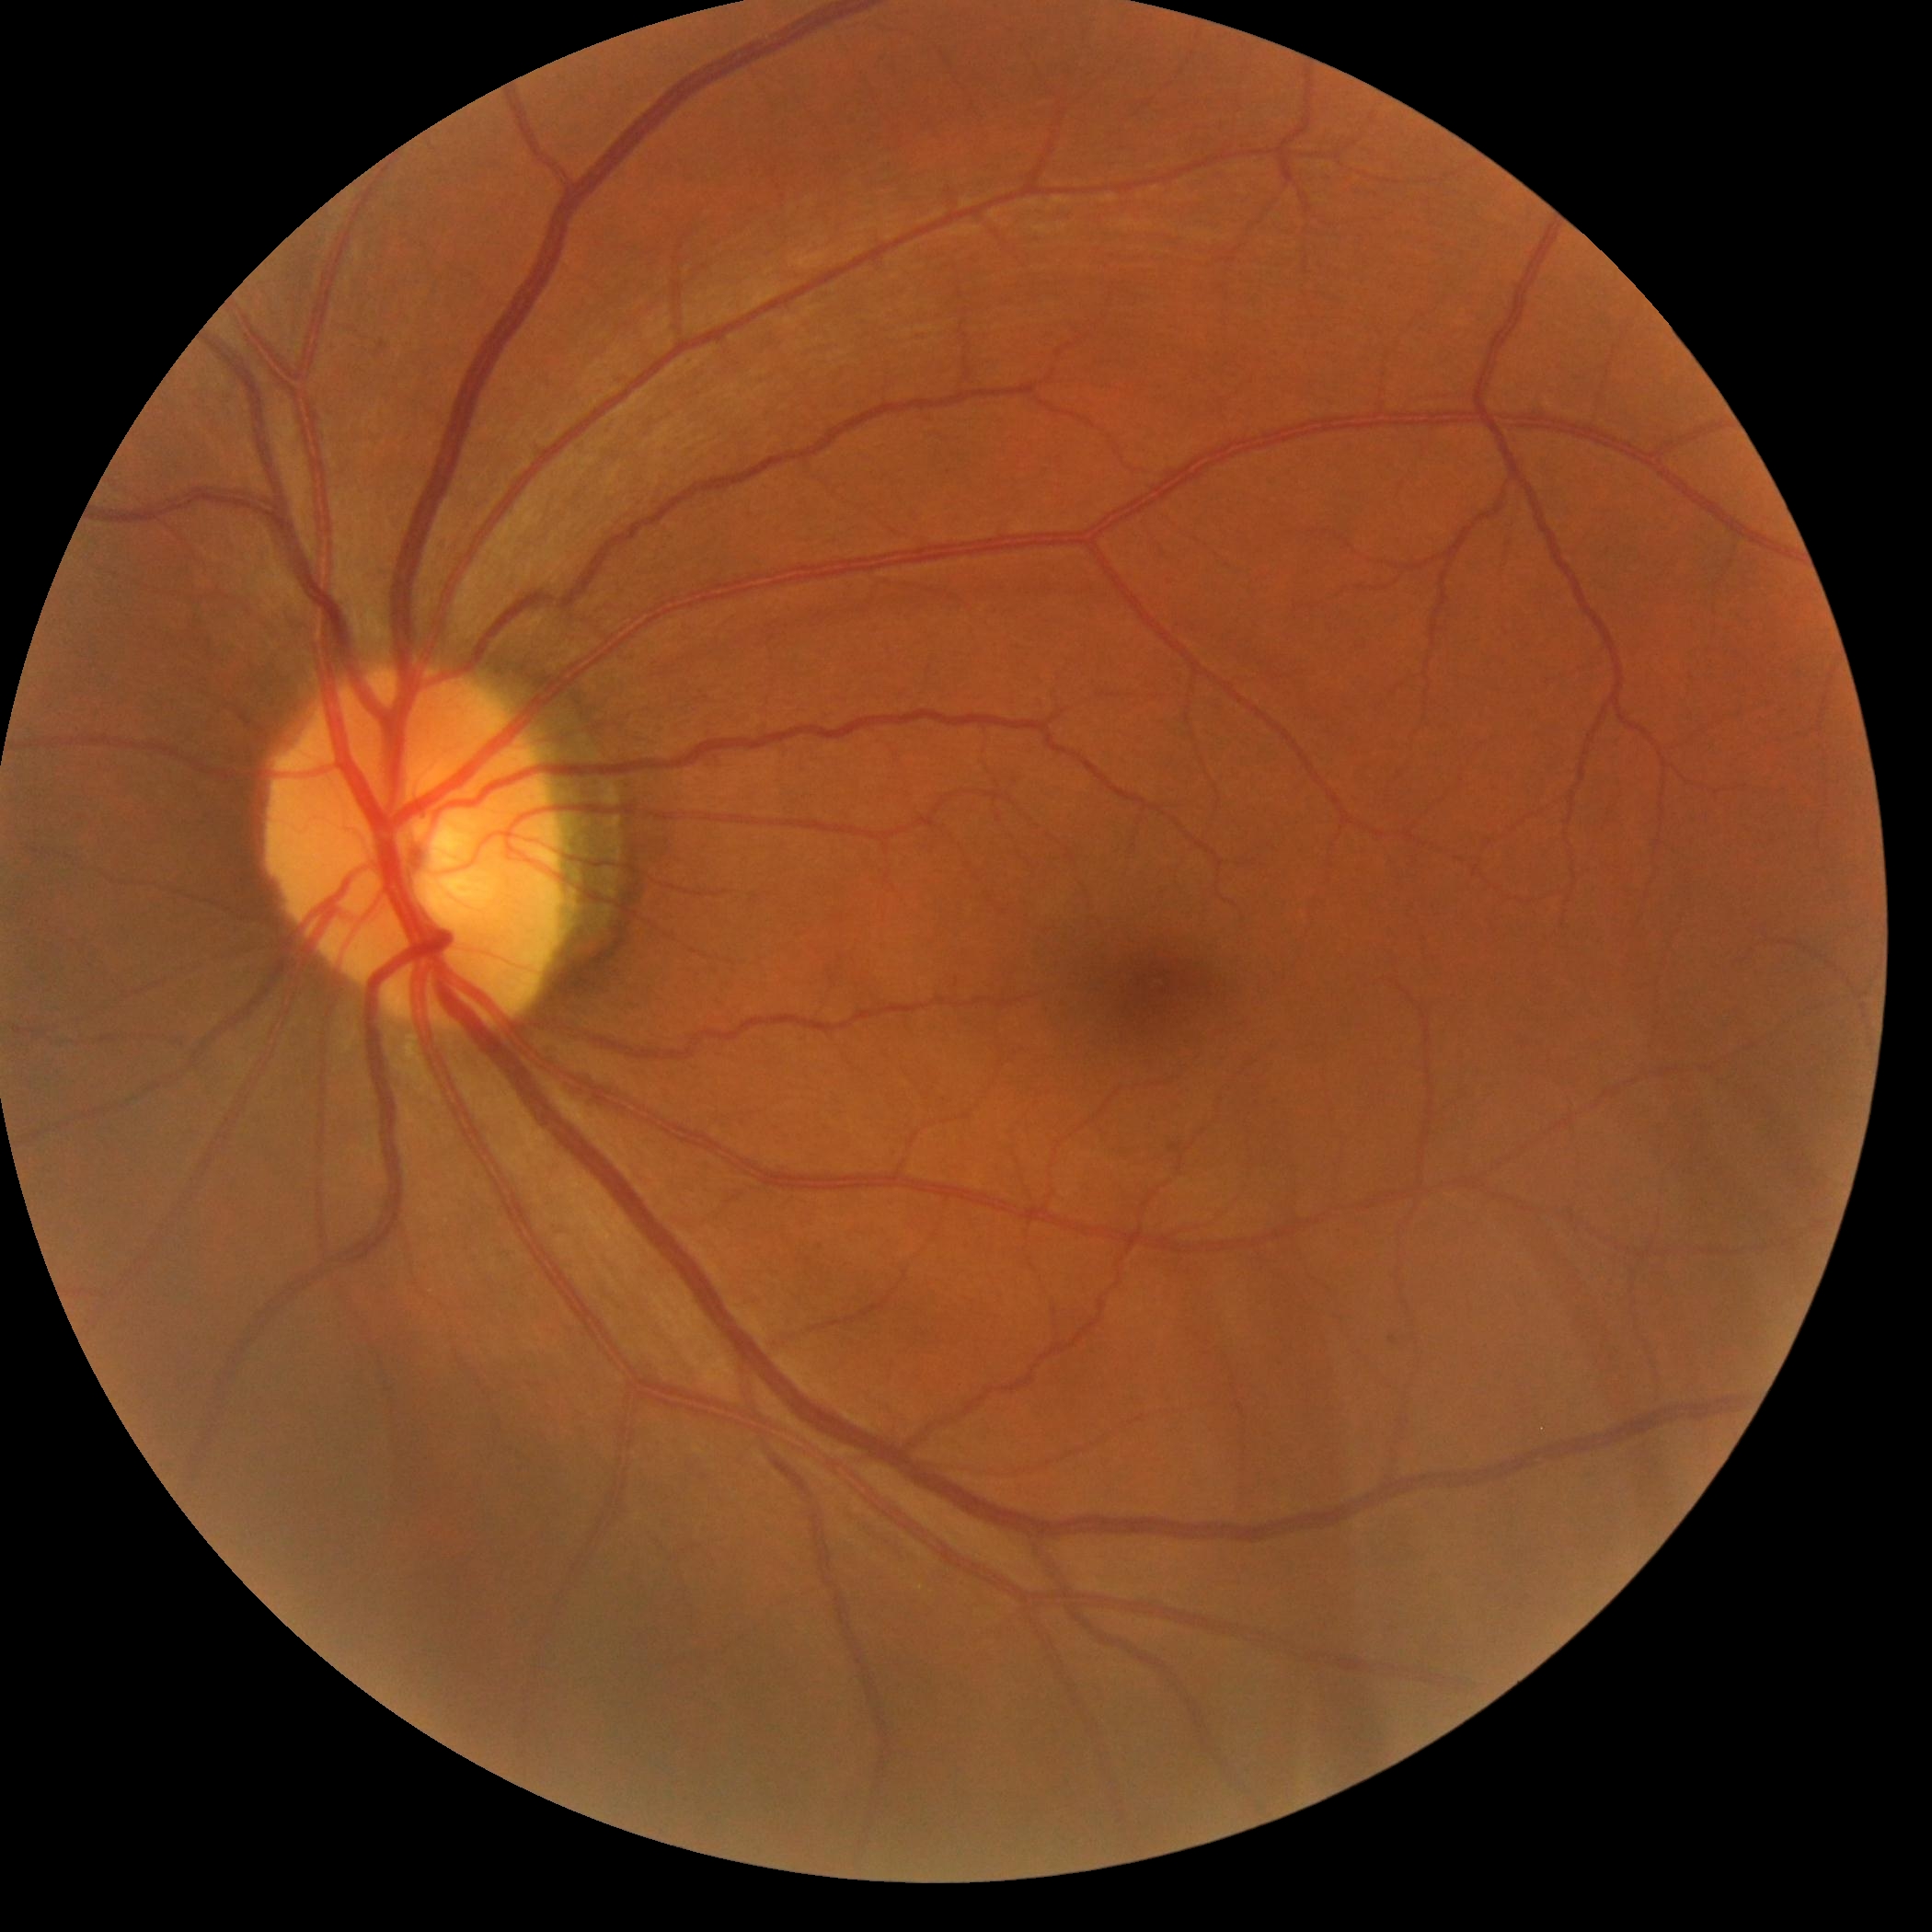
diabetic retinopathy severity@grade 0 — no visible signs of diabetic retinopathy, DR impression@no apparent DR.